2352x1568 — 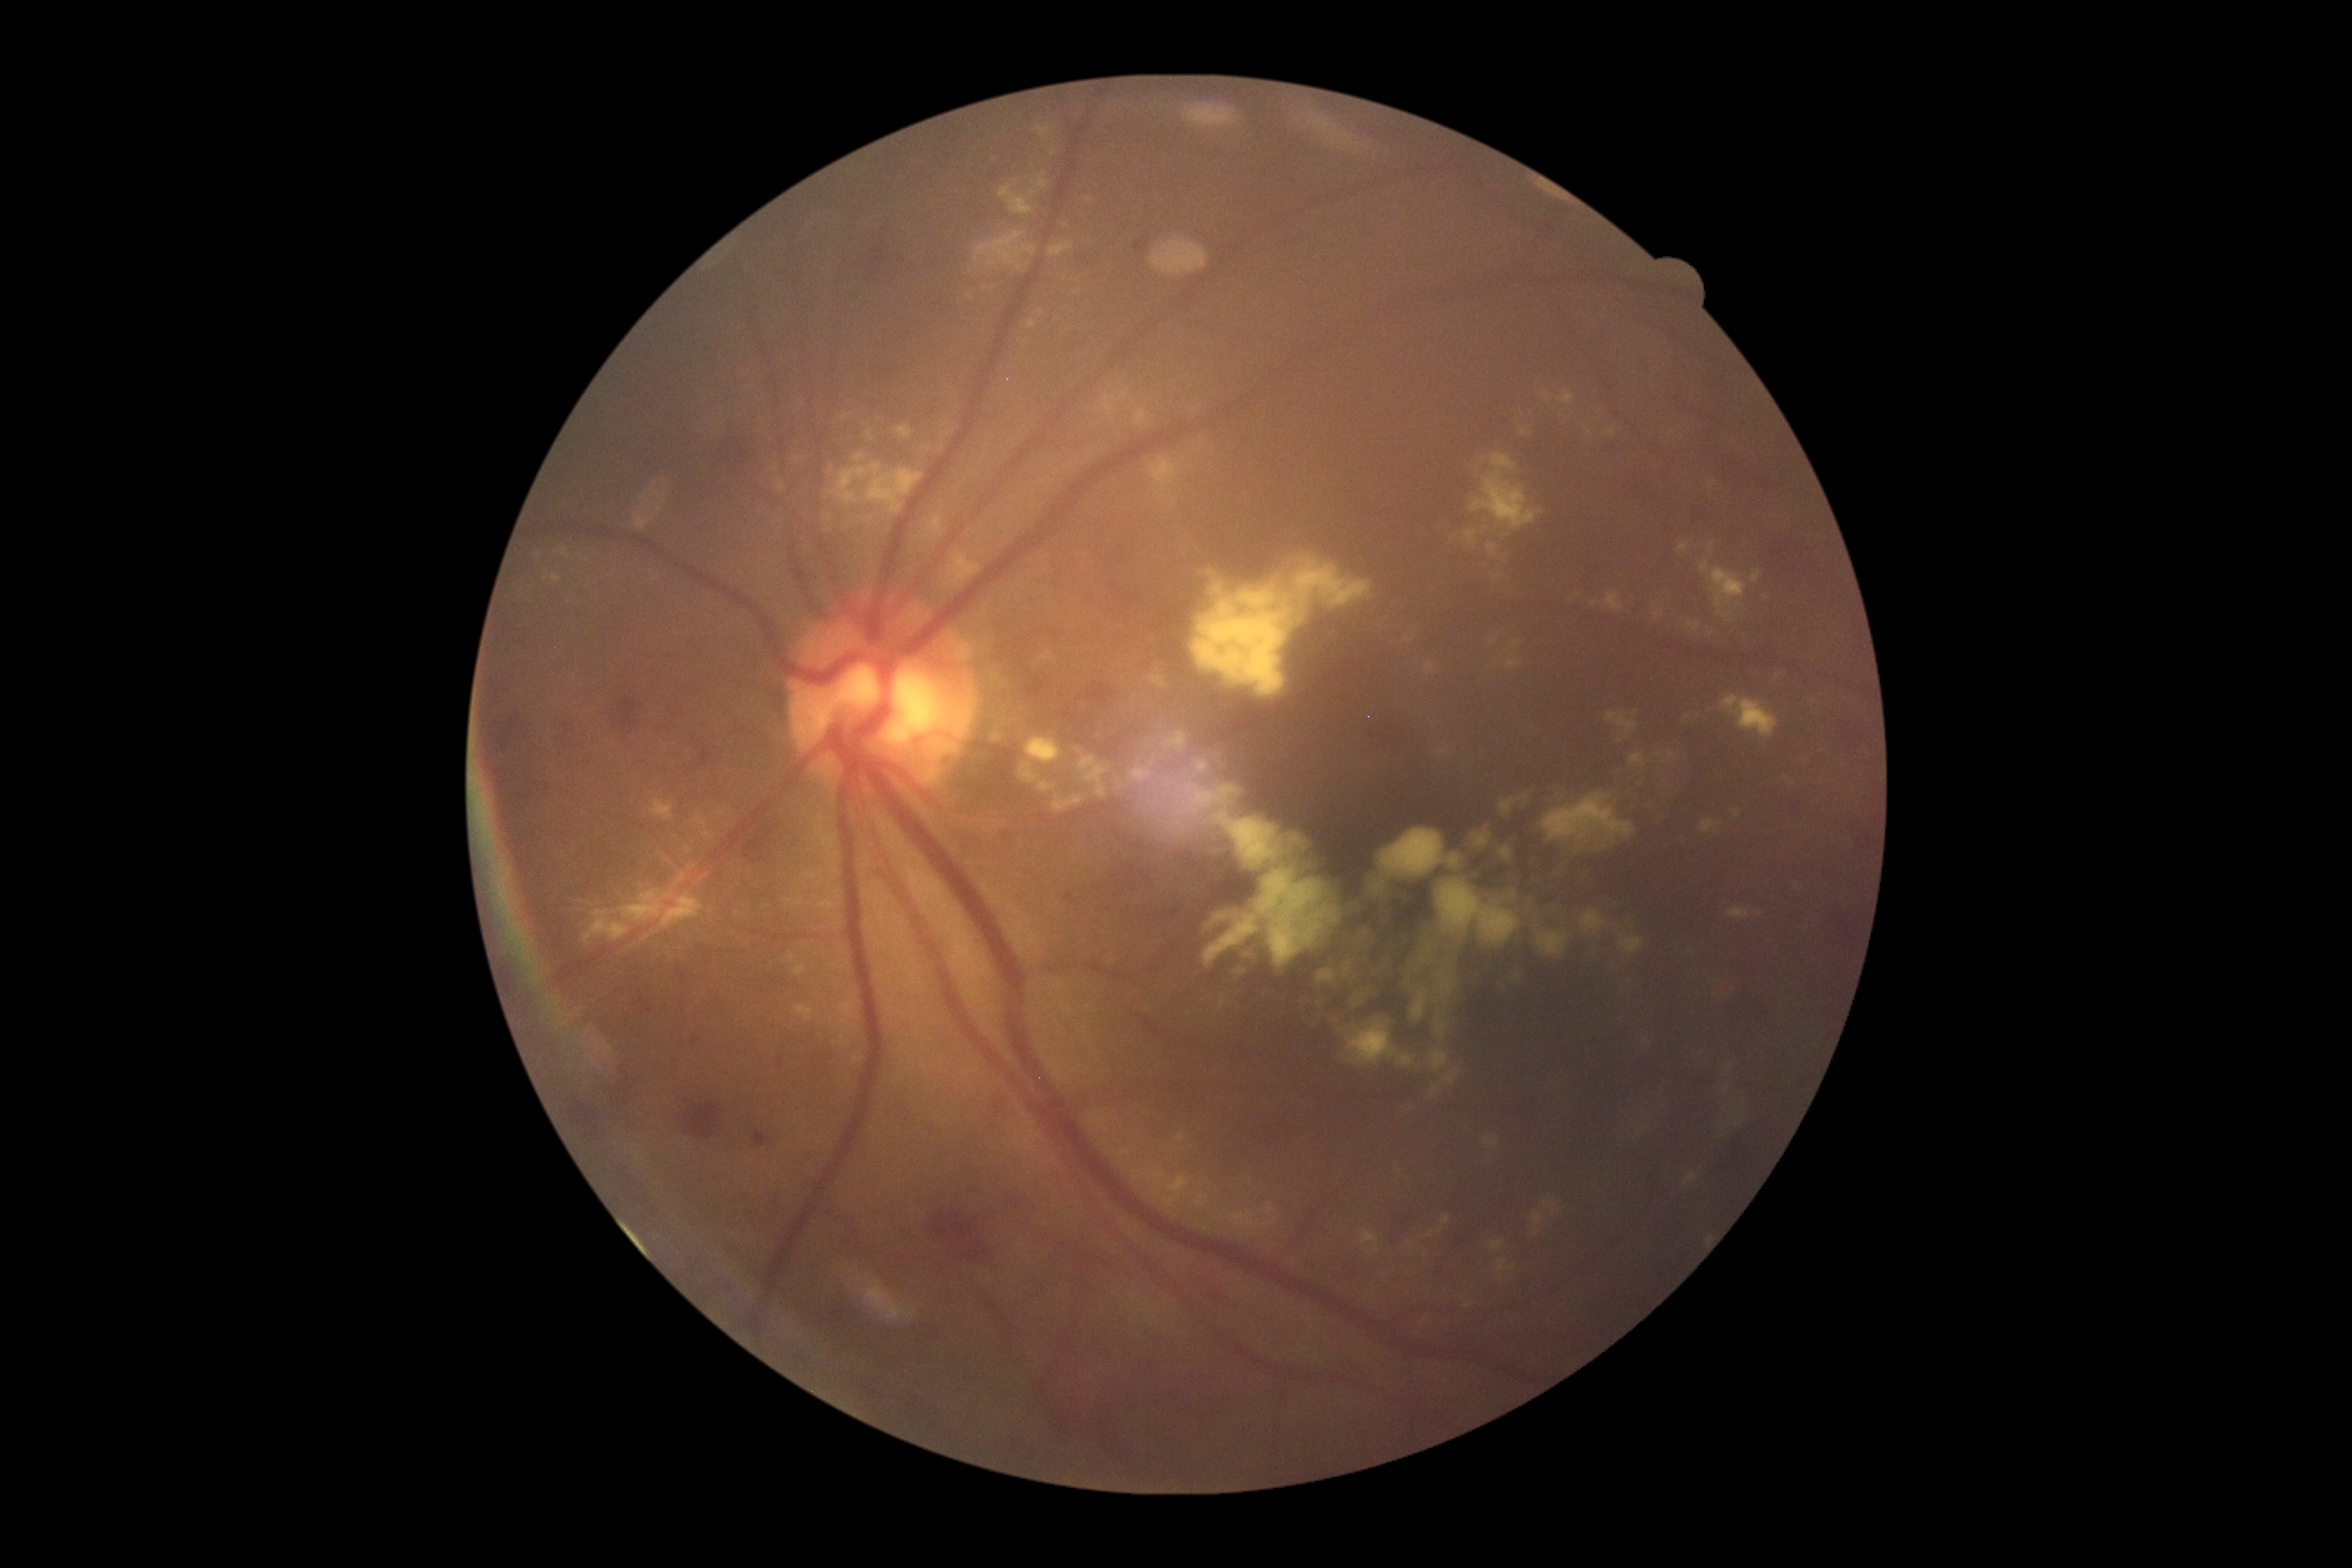

DR severity is 2
A subset of detected lesions:
EXs (subset) = 1700 819 1723 834; 560 549 569 558; 1444 377 1732 680; 834 1037 850 1046; 553 573 562 583; 1482 1137 1500 1148; 1727 908 1750 921; 703 832 712 839; 1369 611 1442 681; 1674 529 1779 652; 1231 1210 1280 1231; 854 1052 865 1064
Small EXs approximately at <point>1797, 887</point>; <point>1759, 914</point>